Diabetic retinopathy graded by the modified Davis classification
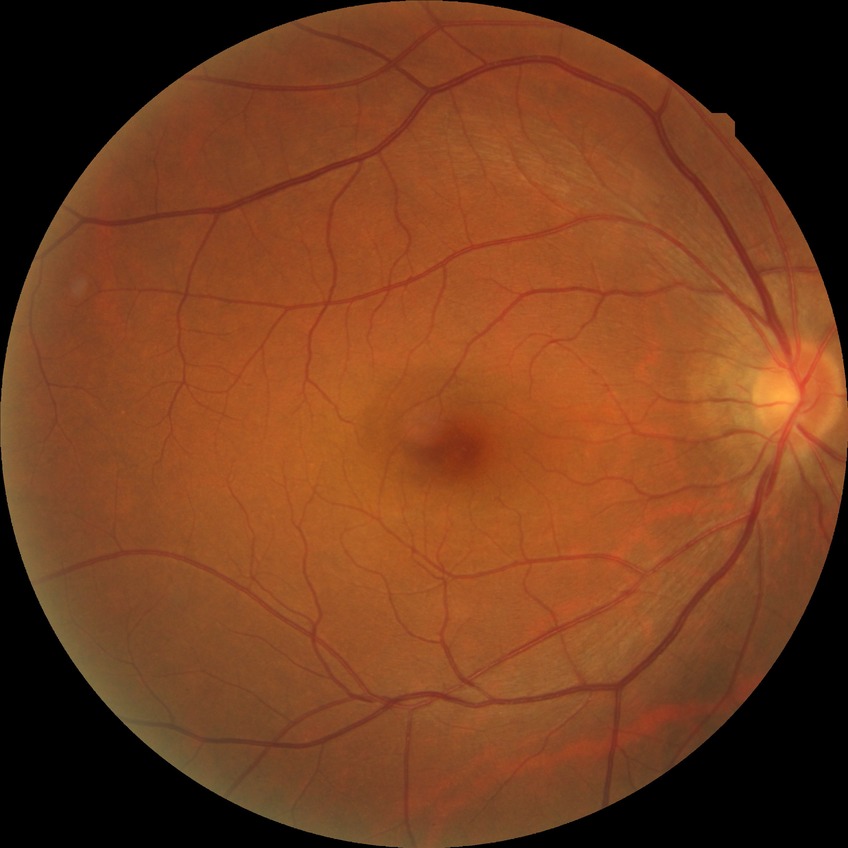 Diabetic retinopathy (DR): no diabetic retinopathy (NDR).